Posterior pole color fundus photograph:
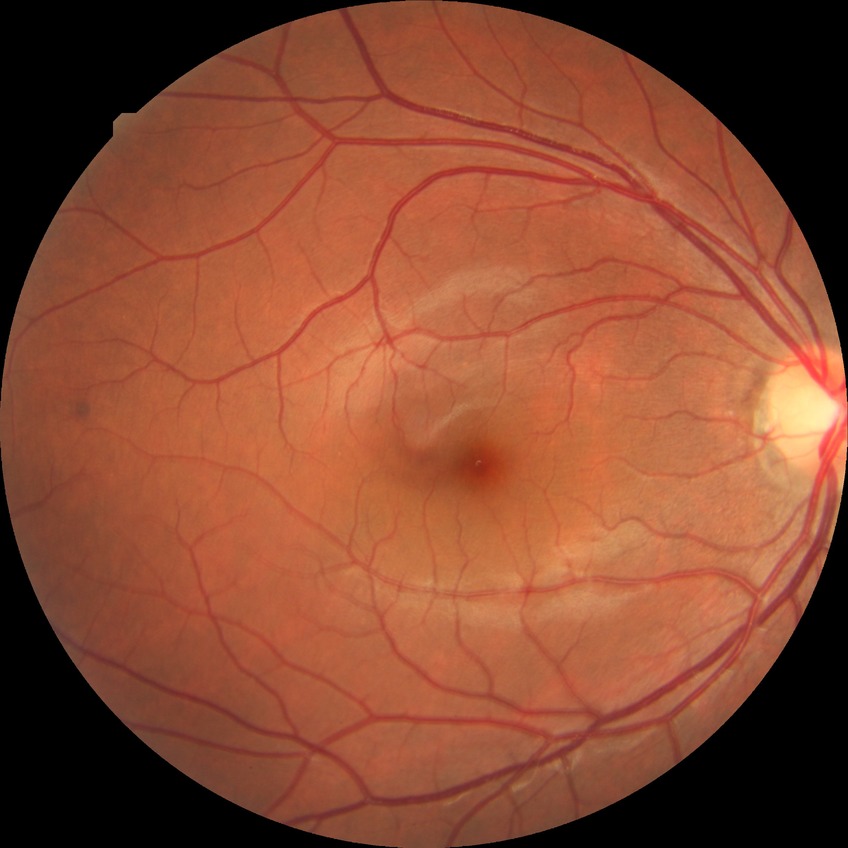

Davis grading is no diabetic retinopathy.